45 degree fundus photograph · camera: NIDEK AFC-230 · 848x848 · modified Davis classification · nonmydriatic fundus photograph.
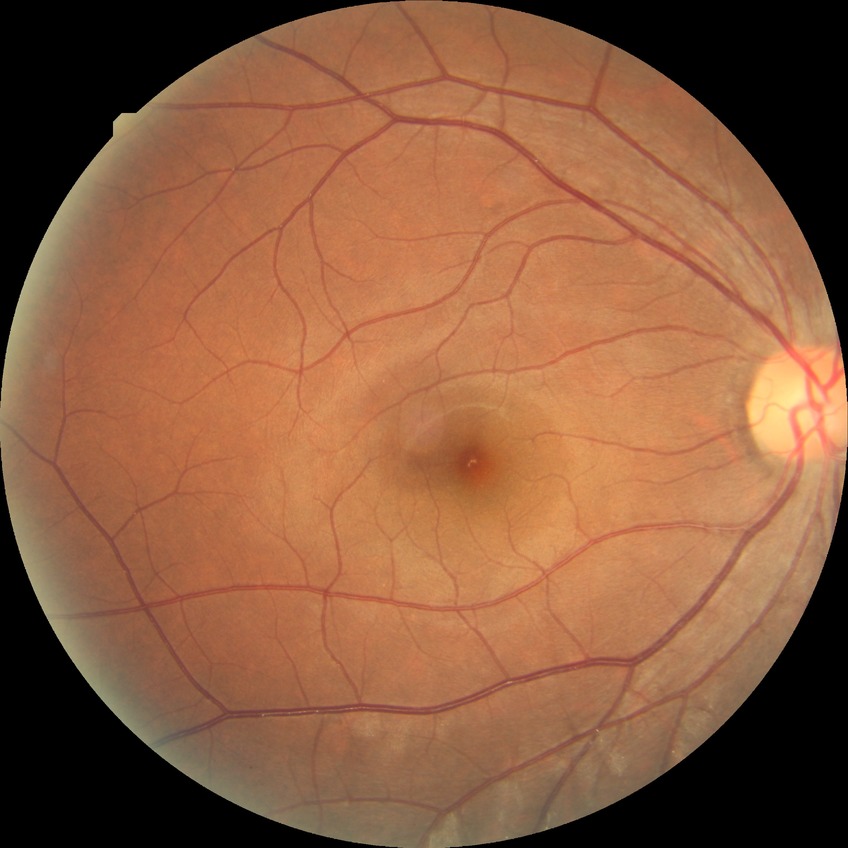

Diabetic retinopathy (DR) is no diabetic retinopathy (NDR).